Topcon TRC-50DX. 2228 by 1652 pixels. Mydriatic (tropicamide and phenylephrine). Fundus photo. Field includes the optic disc and macula. FOV: 50 degrees:
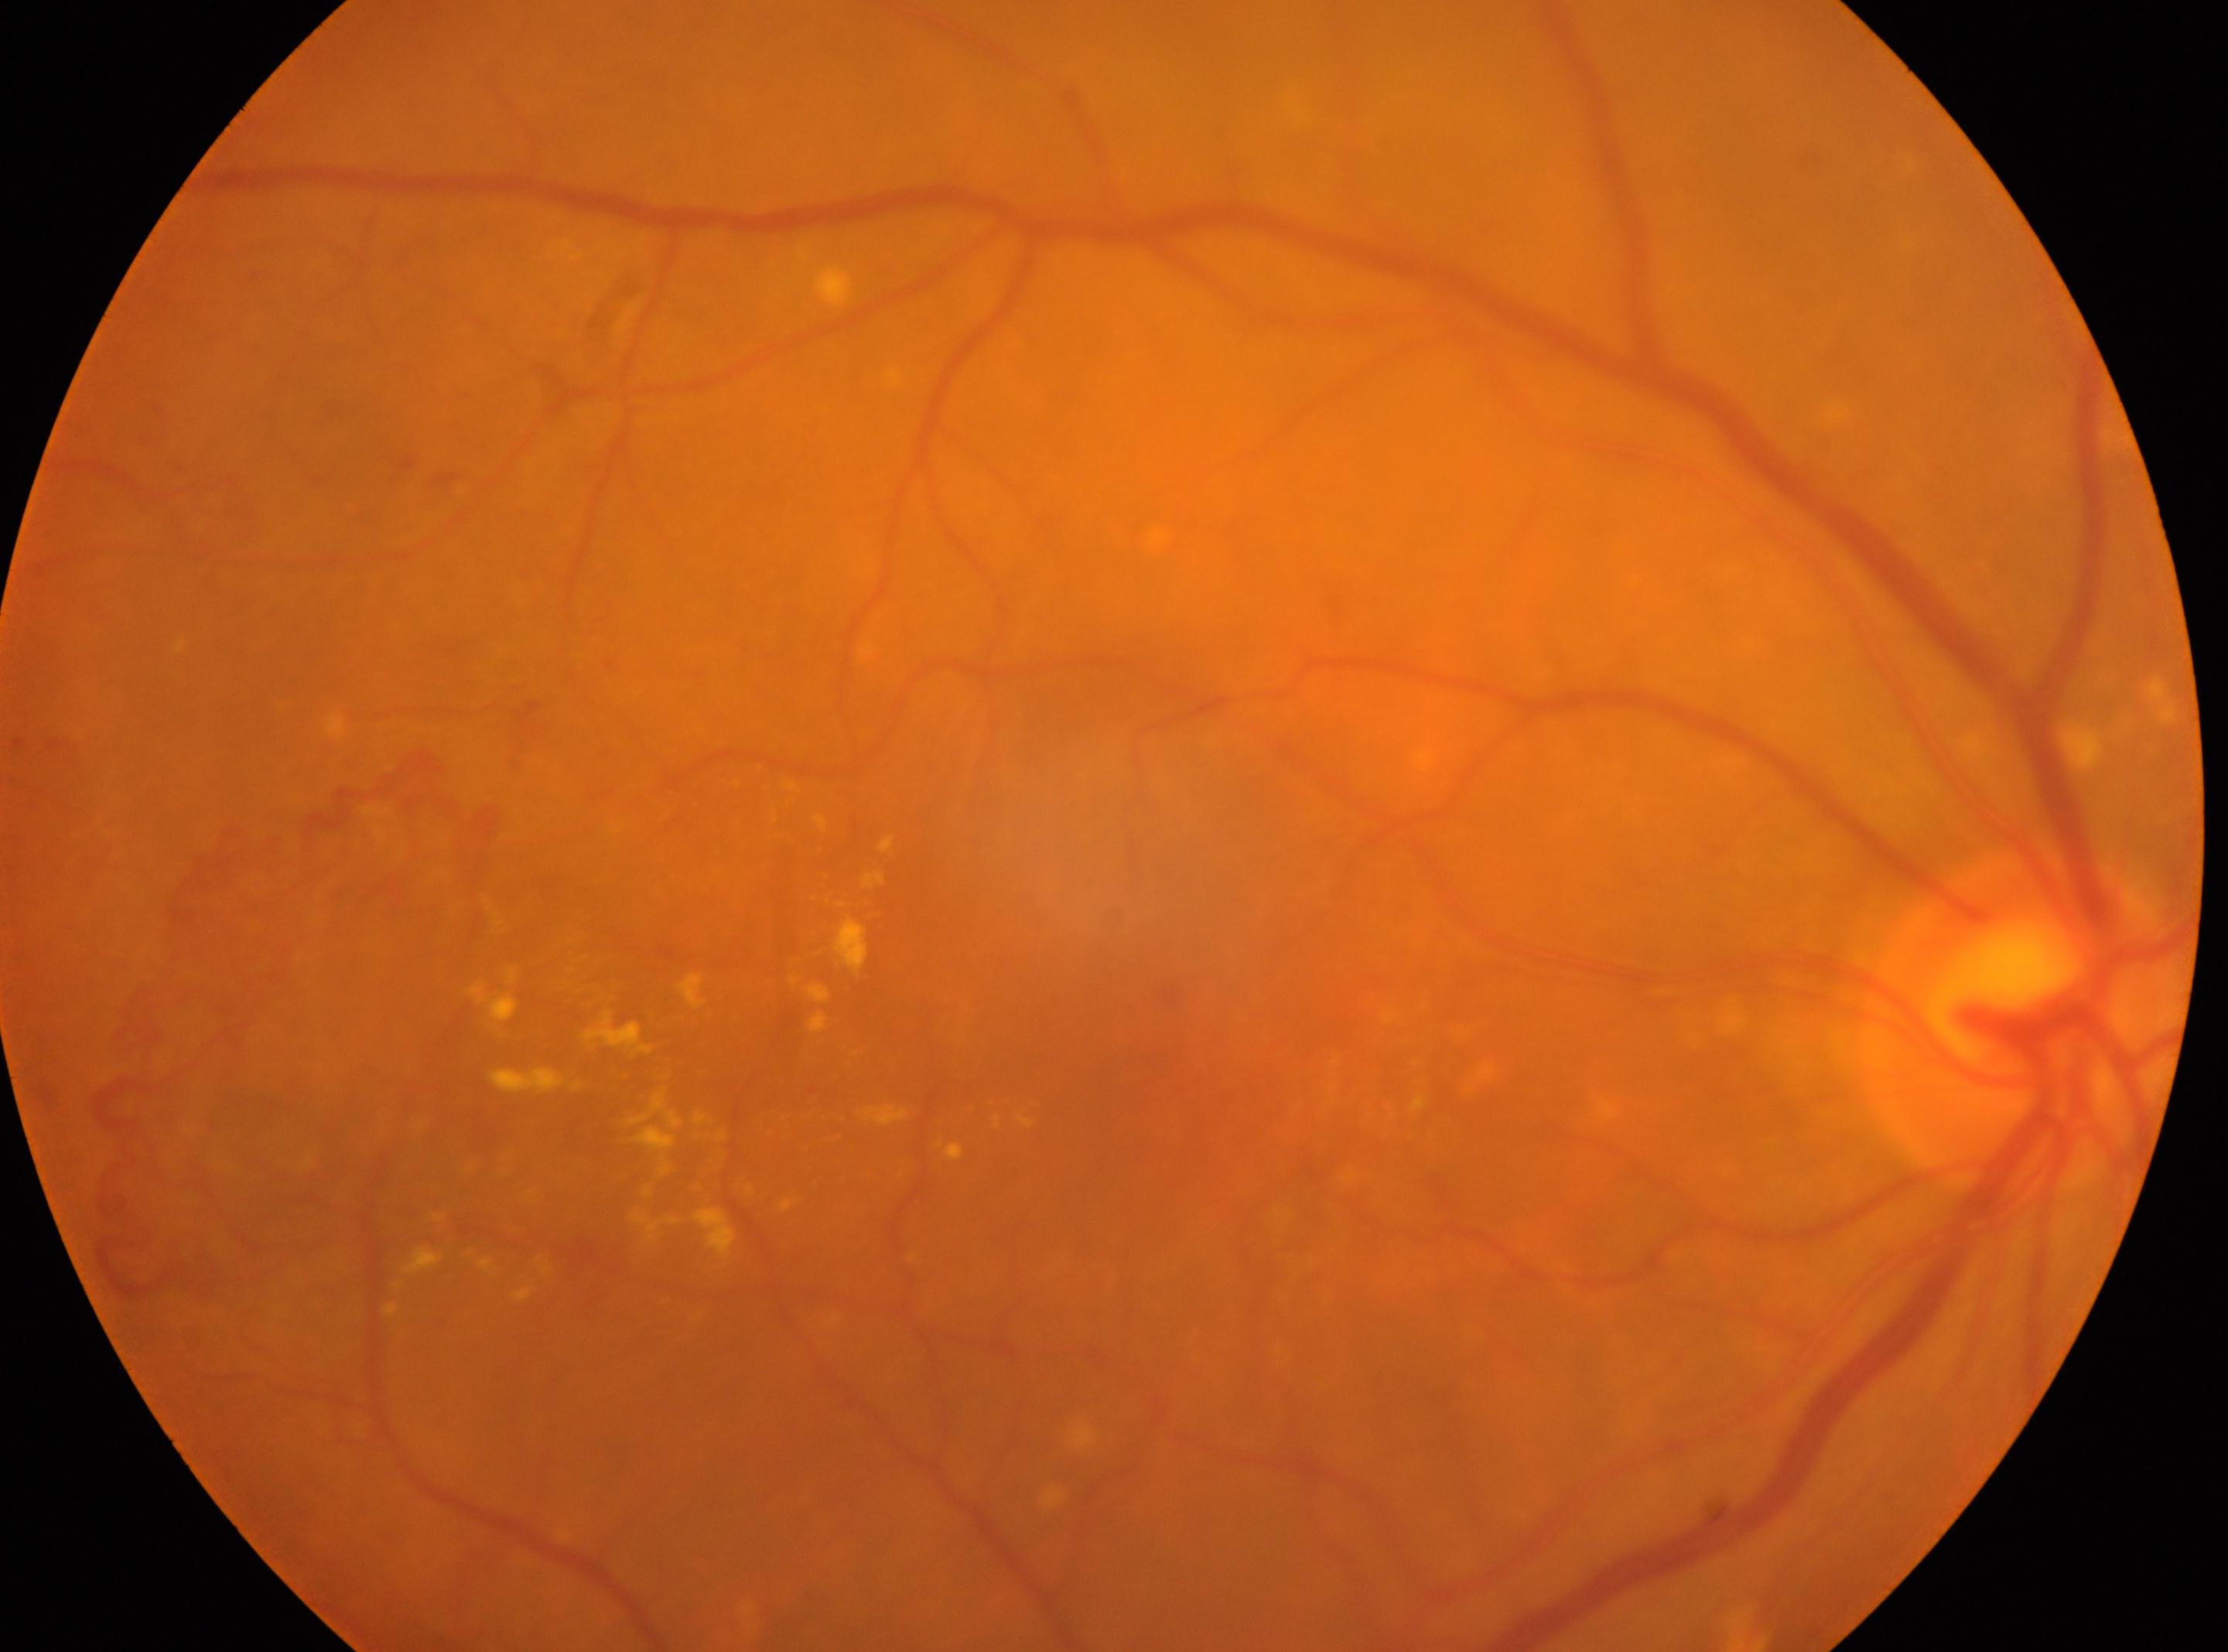 The retinopathy is classified as proliferative diabetic retinopathy.
Optic disk located at (2021, 1020).
Macula center located at (1129, 1067).
The image shows the right eye.
DR severity is 4/4.